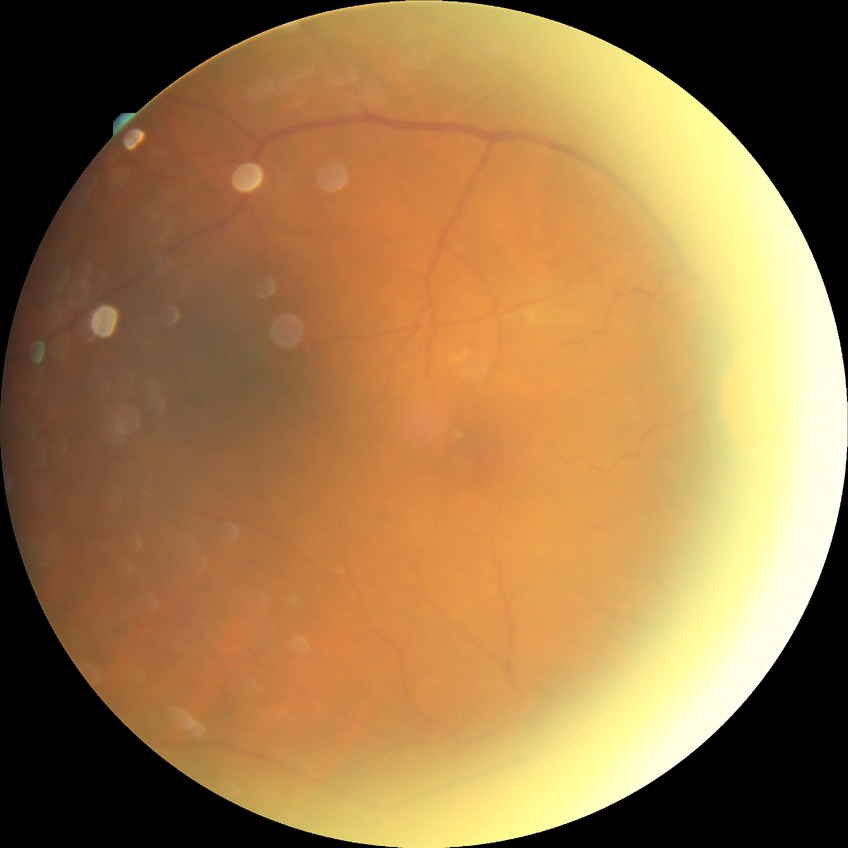

diabetic retinopathy (DR)@simple diabetic retinopathy (SDR).